Color fundus photograph, 512x512 — 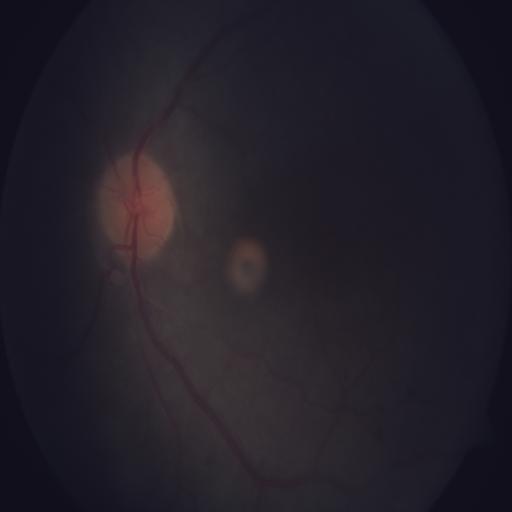
The image shows anterior ischemic optic neuropathy.